Retinal fundus photograph. Camera: NIDEK AFC-230. Nonmydriatic. 45° FOV: 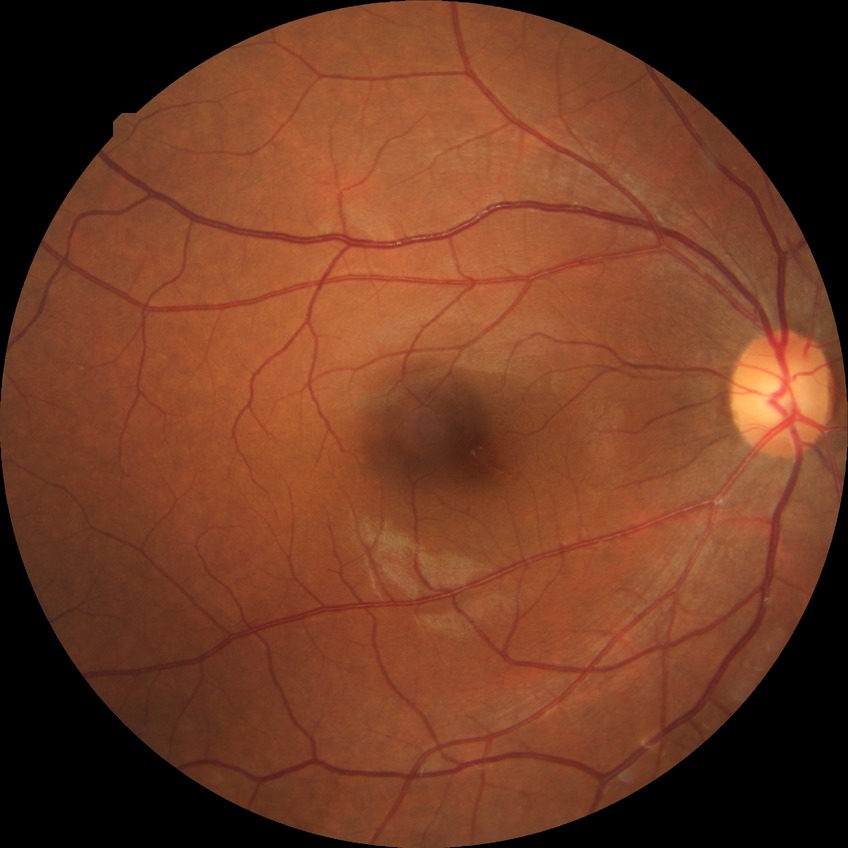

Davis DR grade is NDR.